Optic disc-centered crop. Retinal fundus photograph. 240x240px
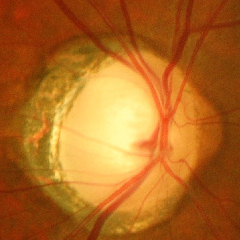 Glaucoma diagnosis: advanced glaucomatous optic neuropathy.